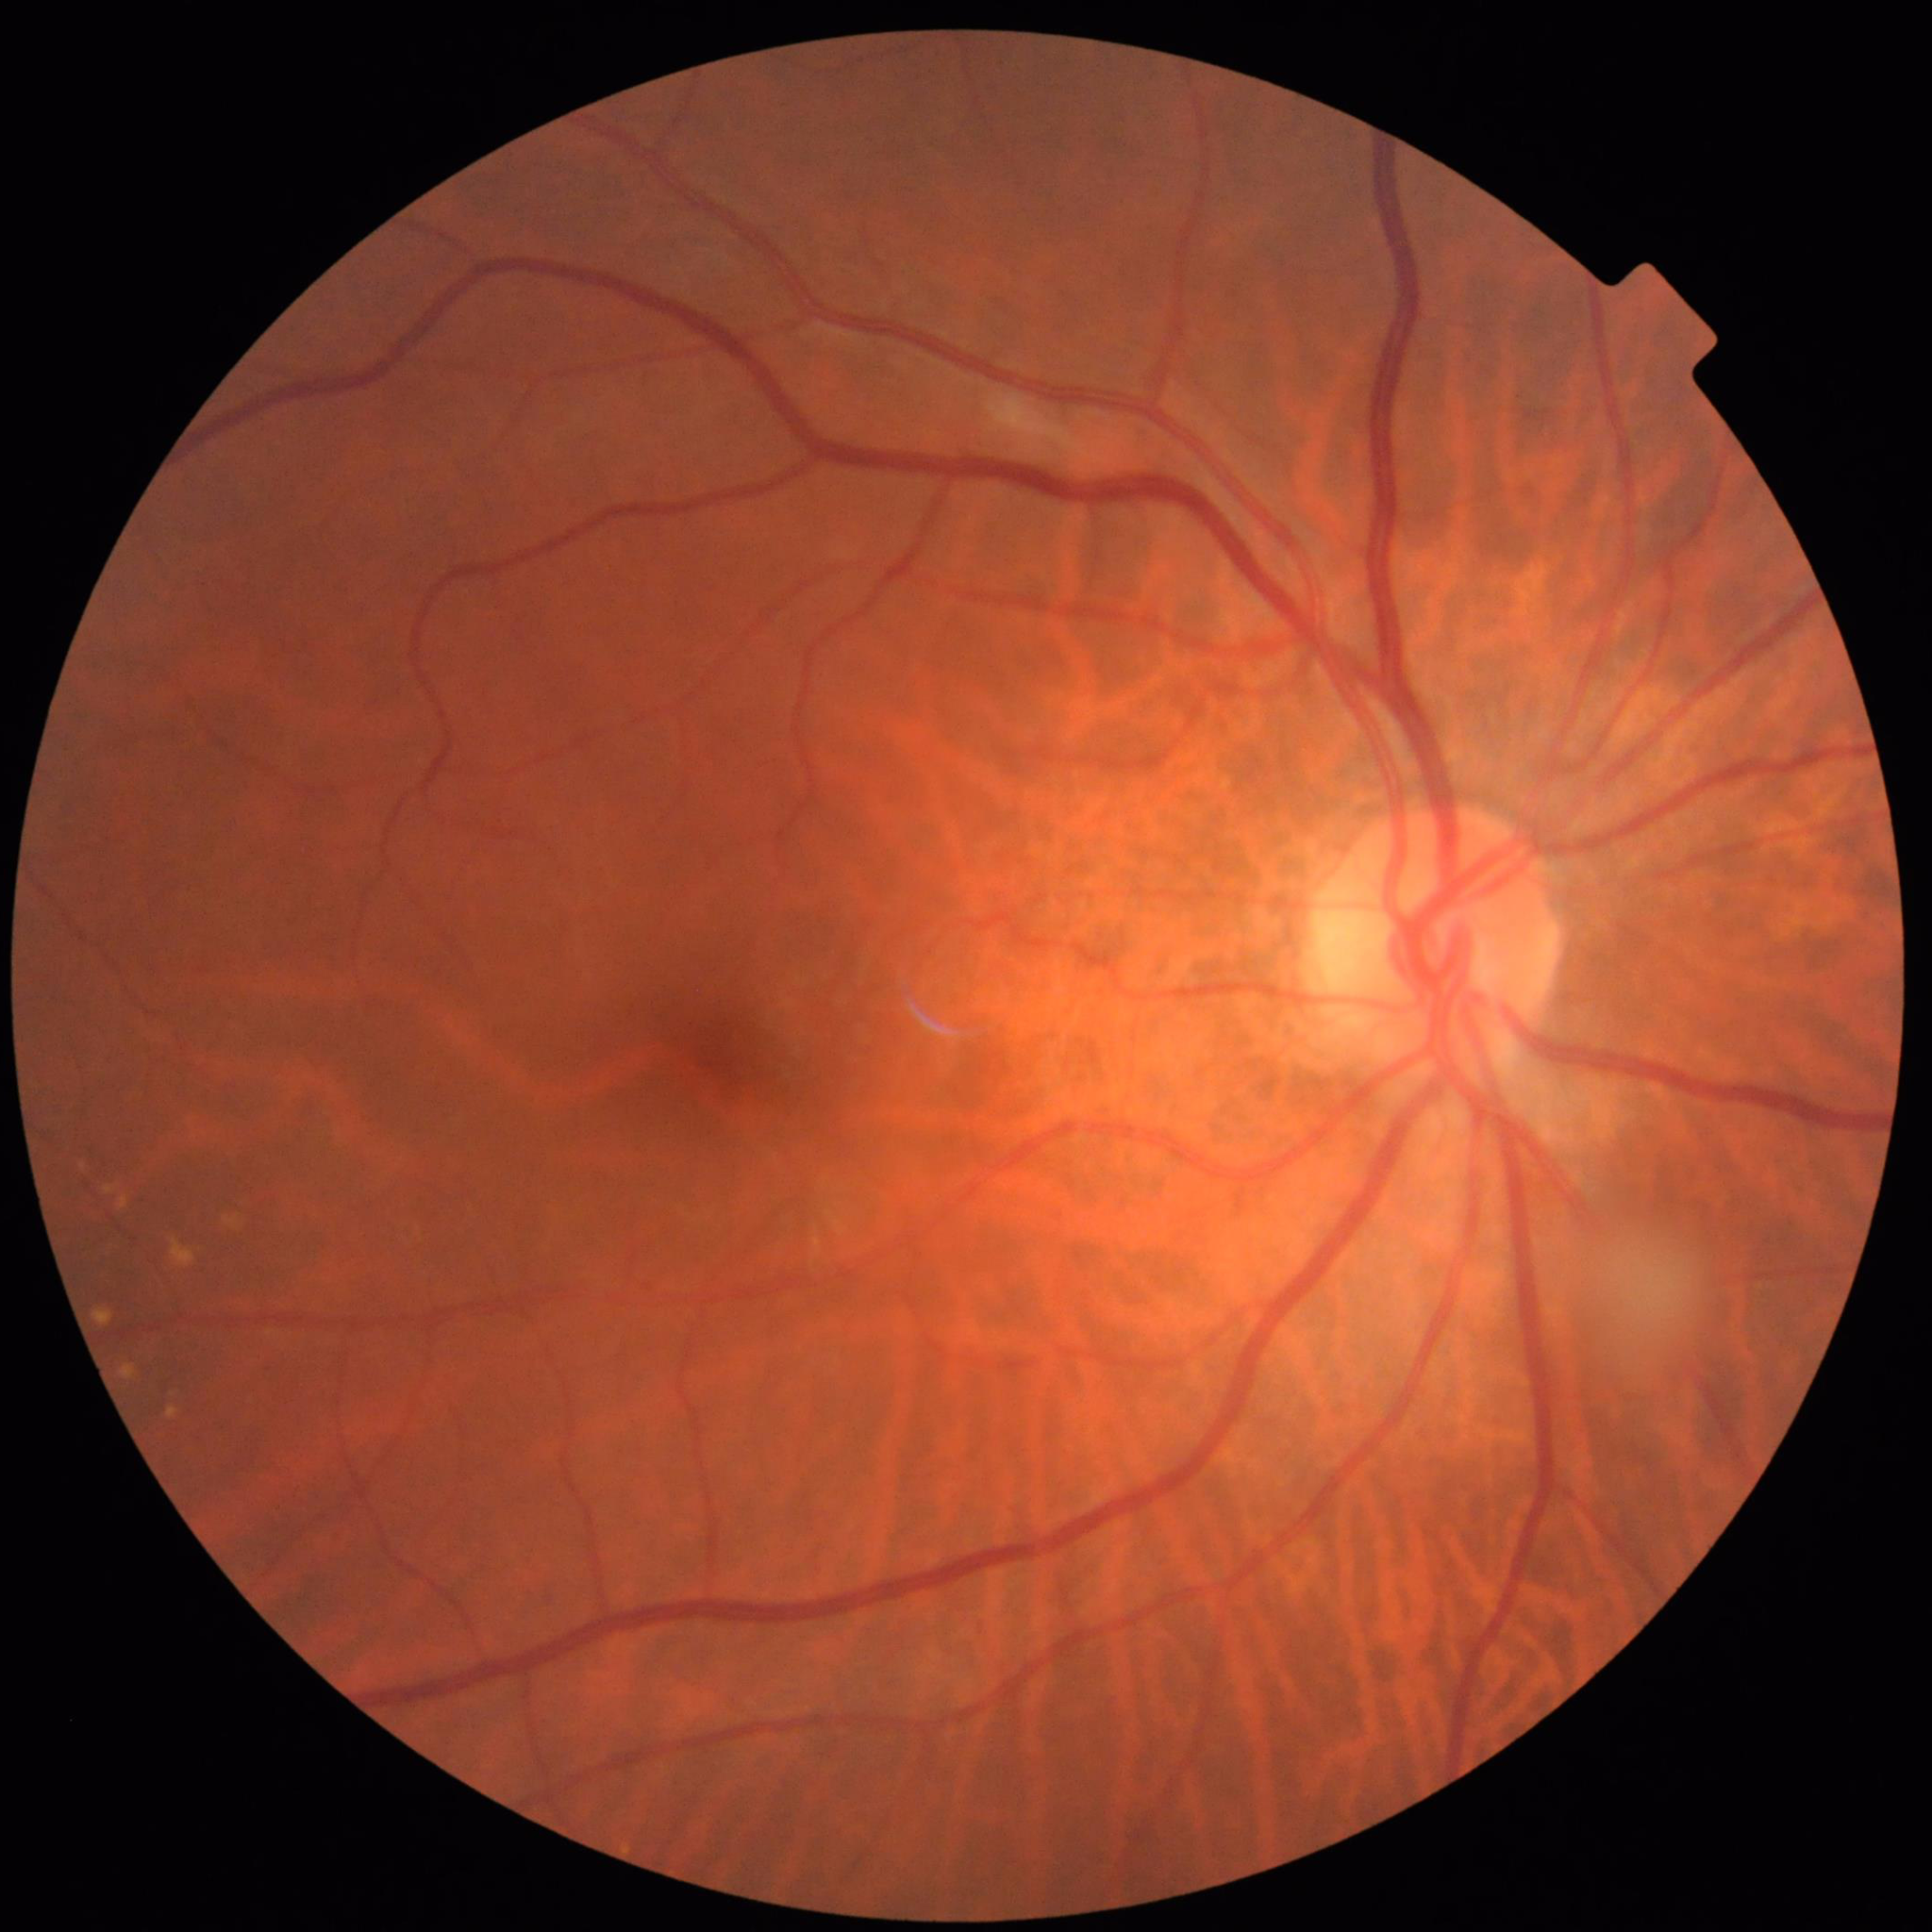

The patient was diagnosed with DR.